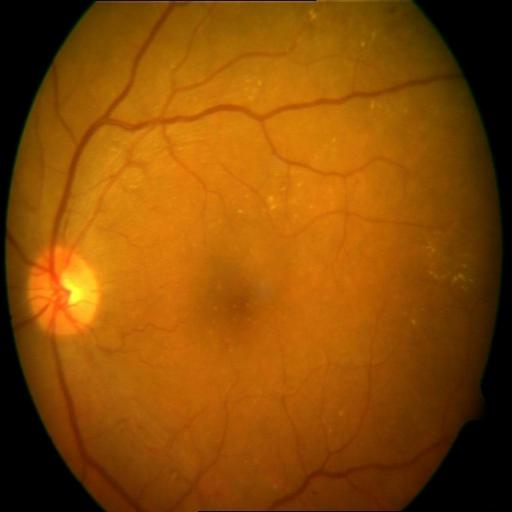

Findings: cystoid macular edema (CME).